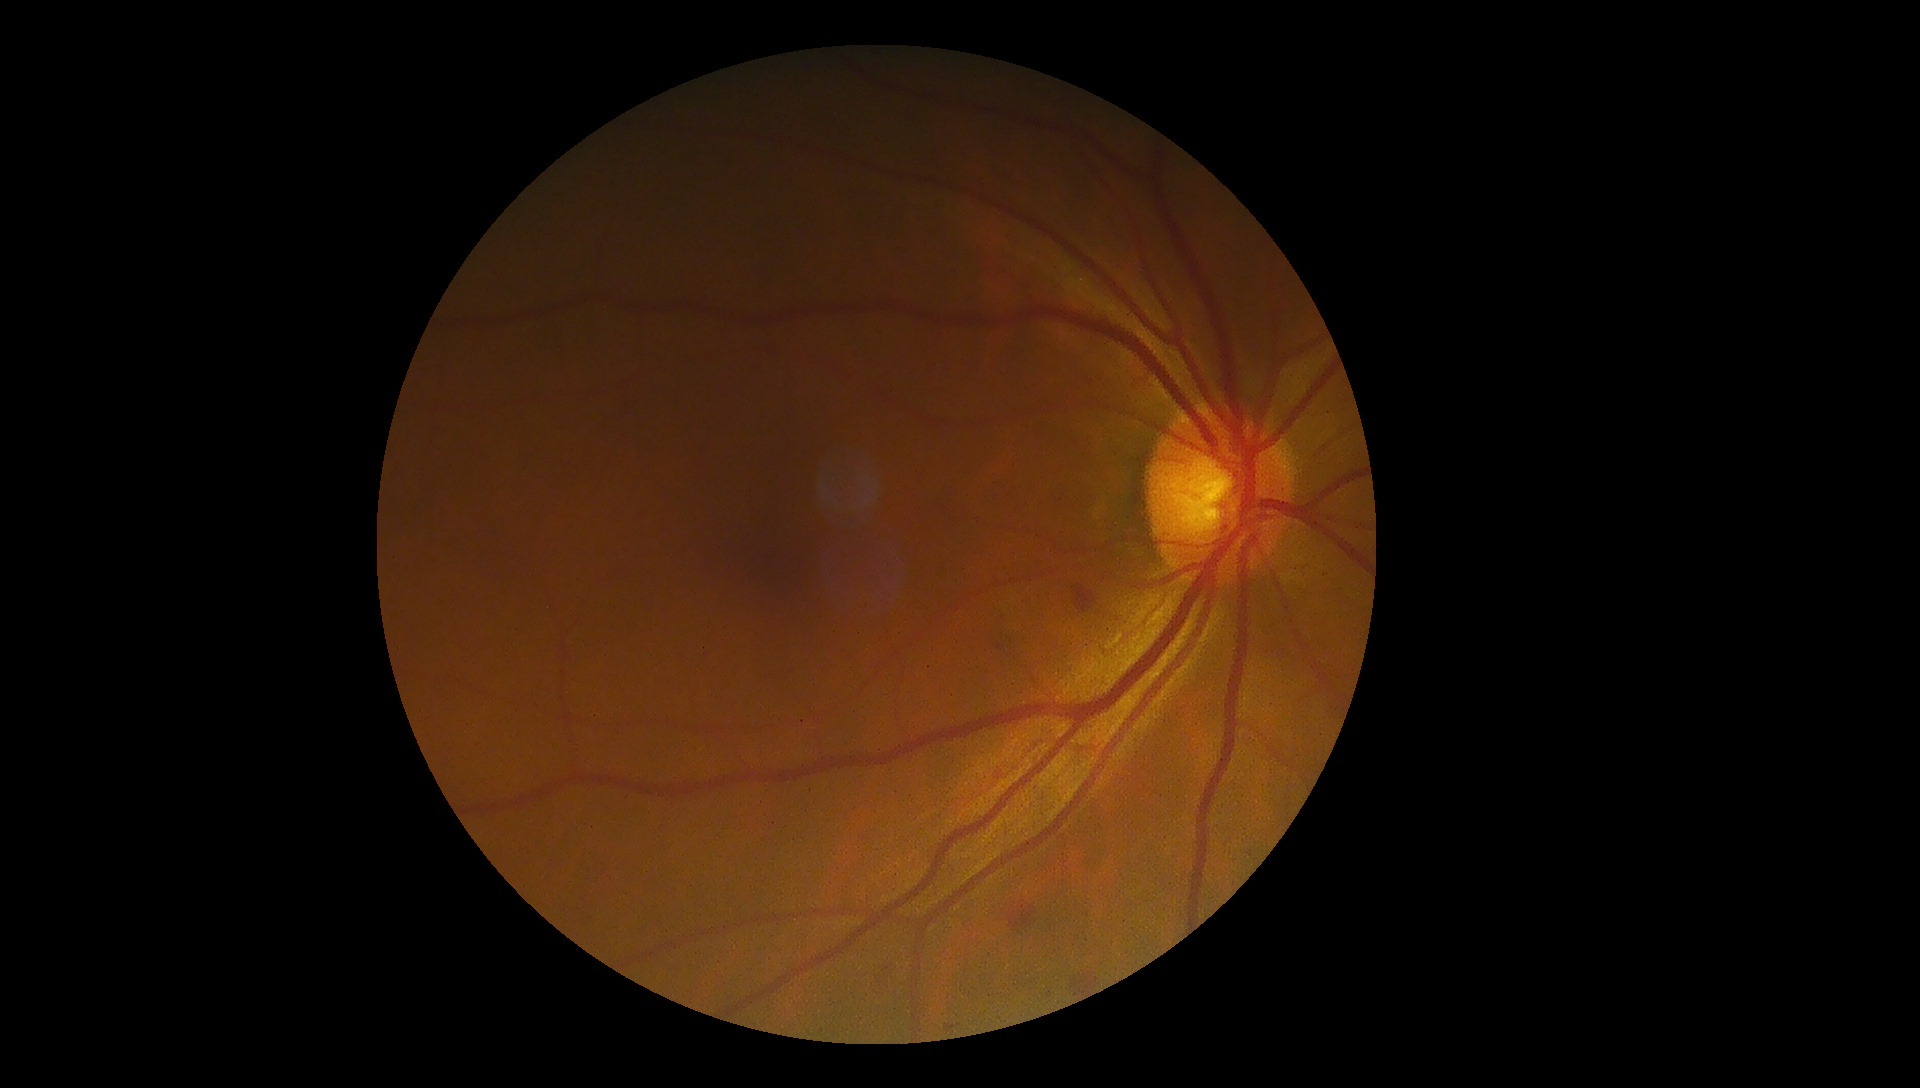 Findings:
– diabetic retinopathy (DR) — grade 2 (moderate NPDR)